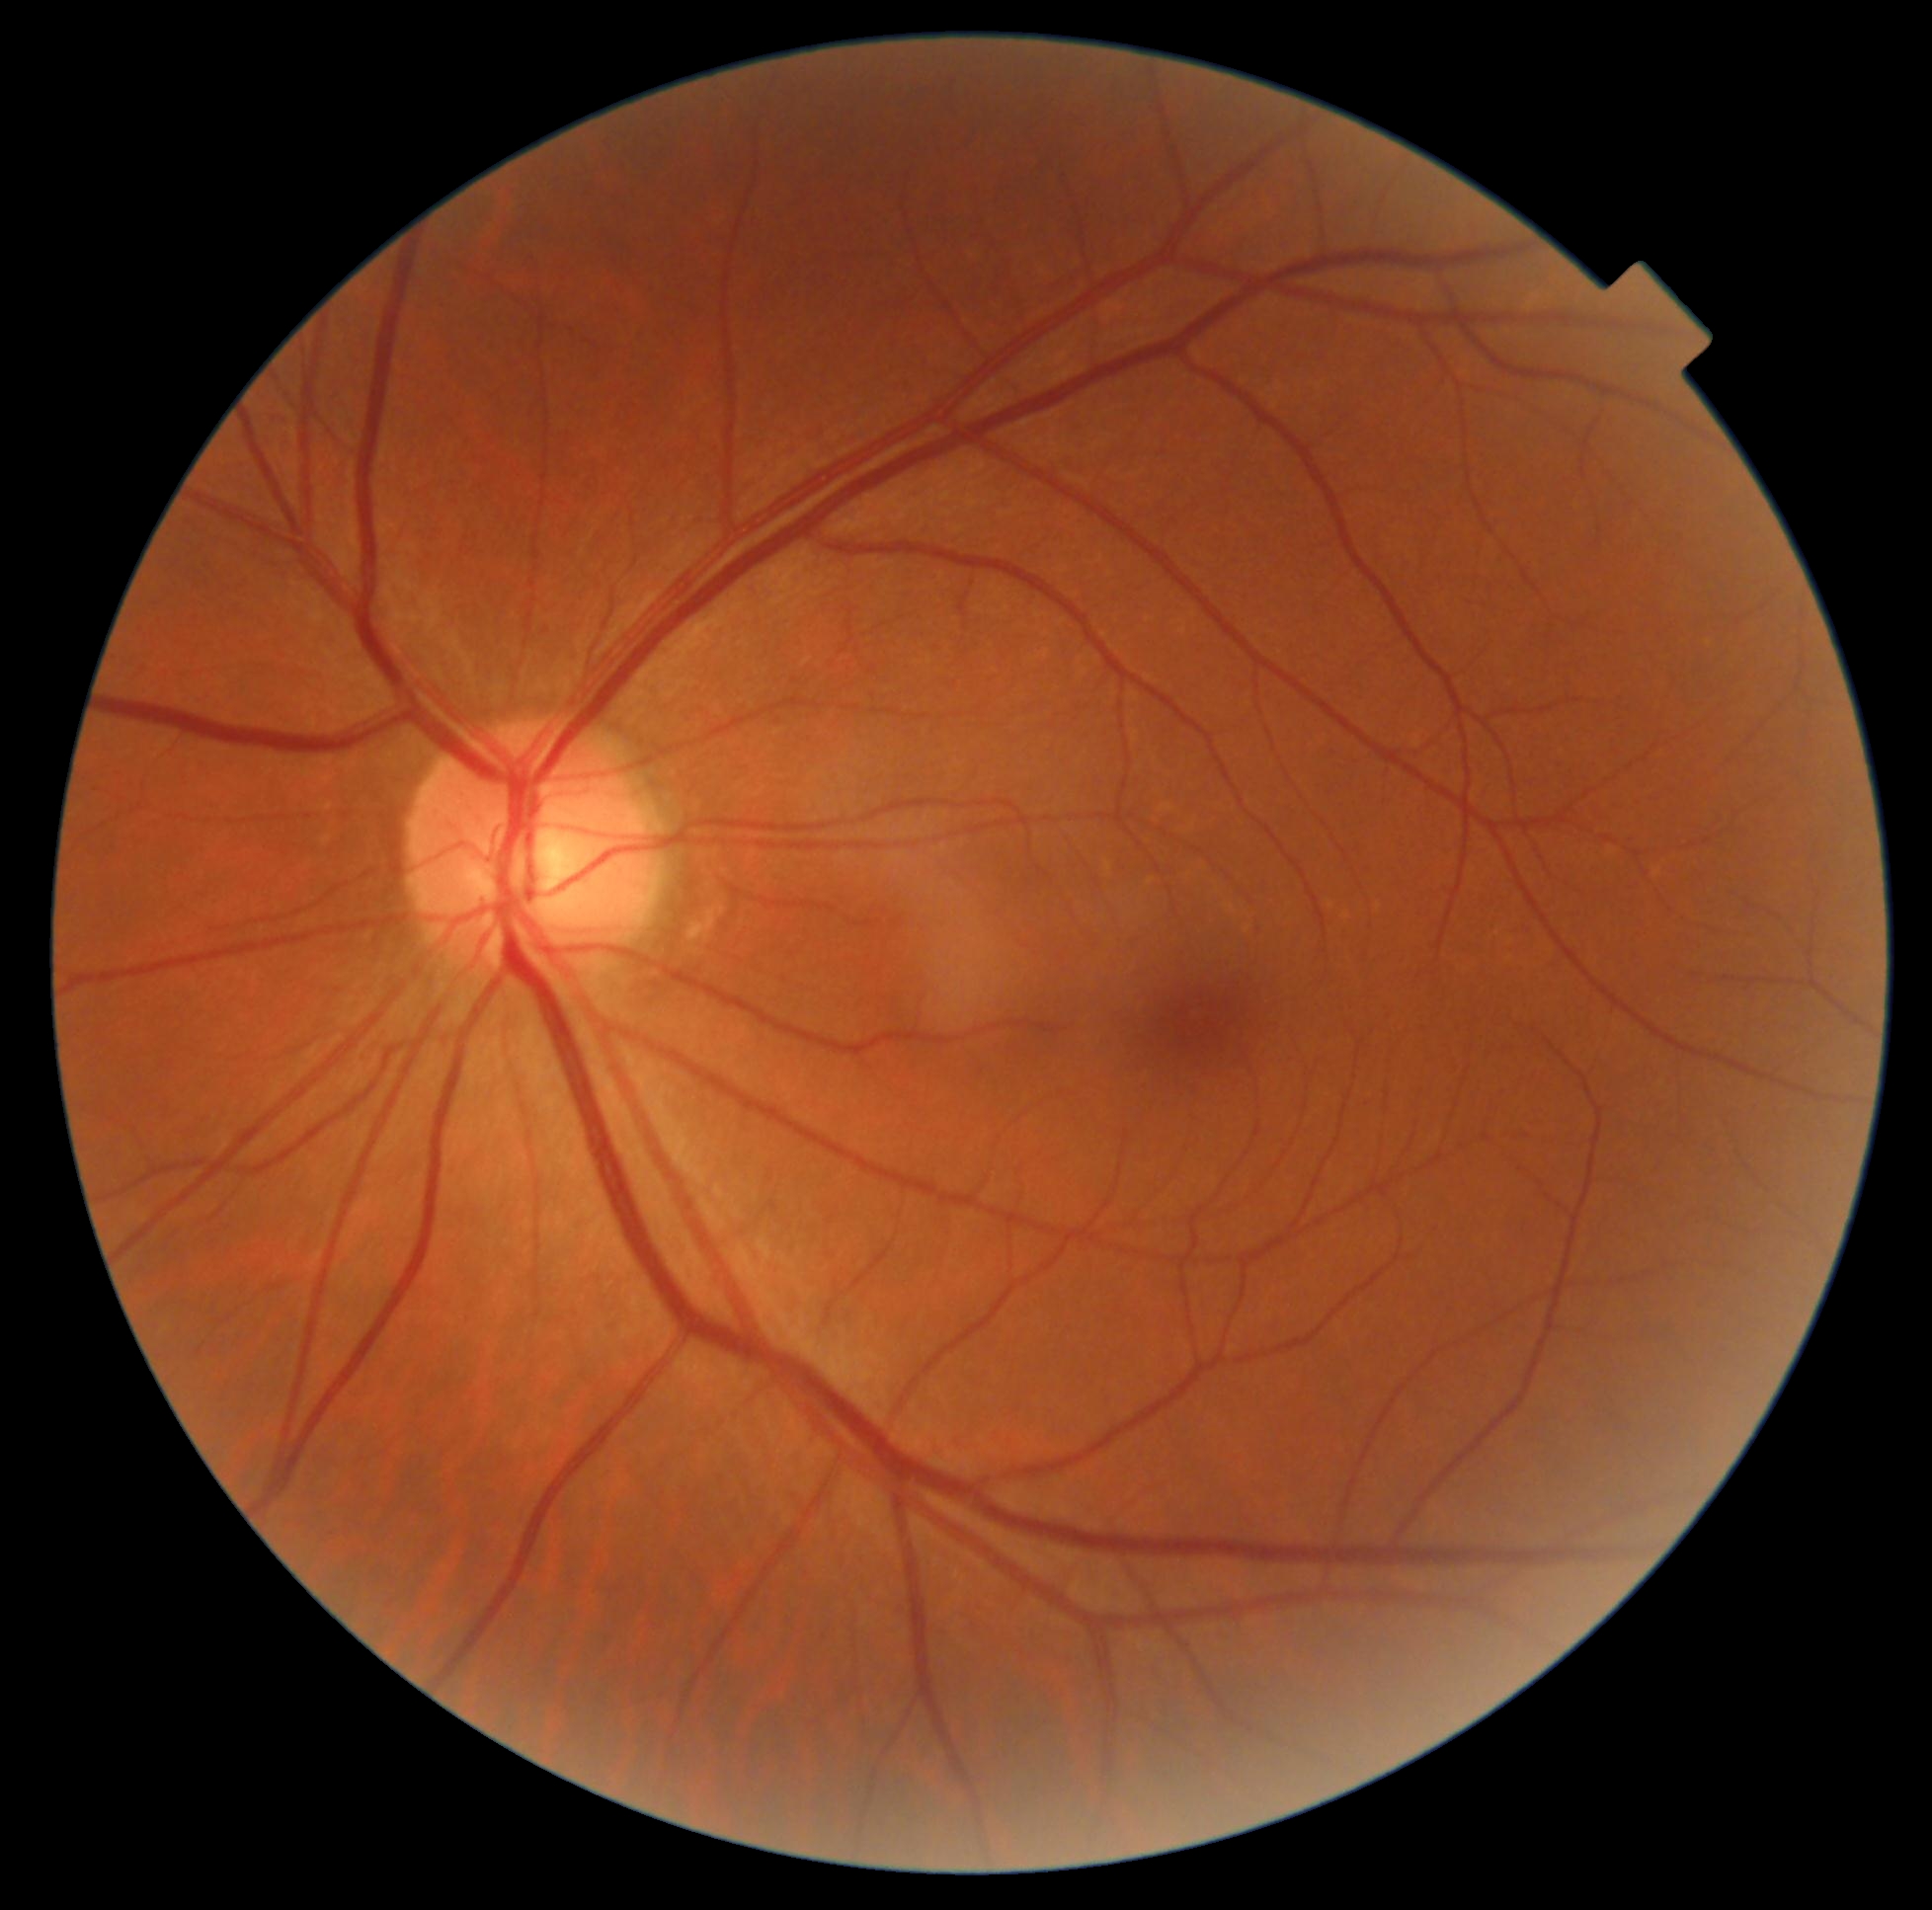
diabetic retinopathy (DR): grade 0 (no apparent retinopathy).